2352 by 1568 pixels:
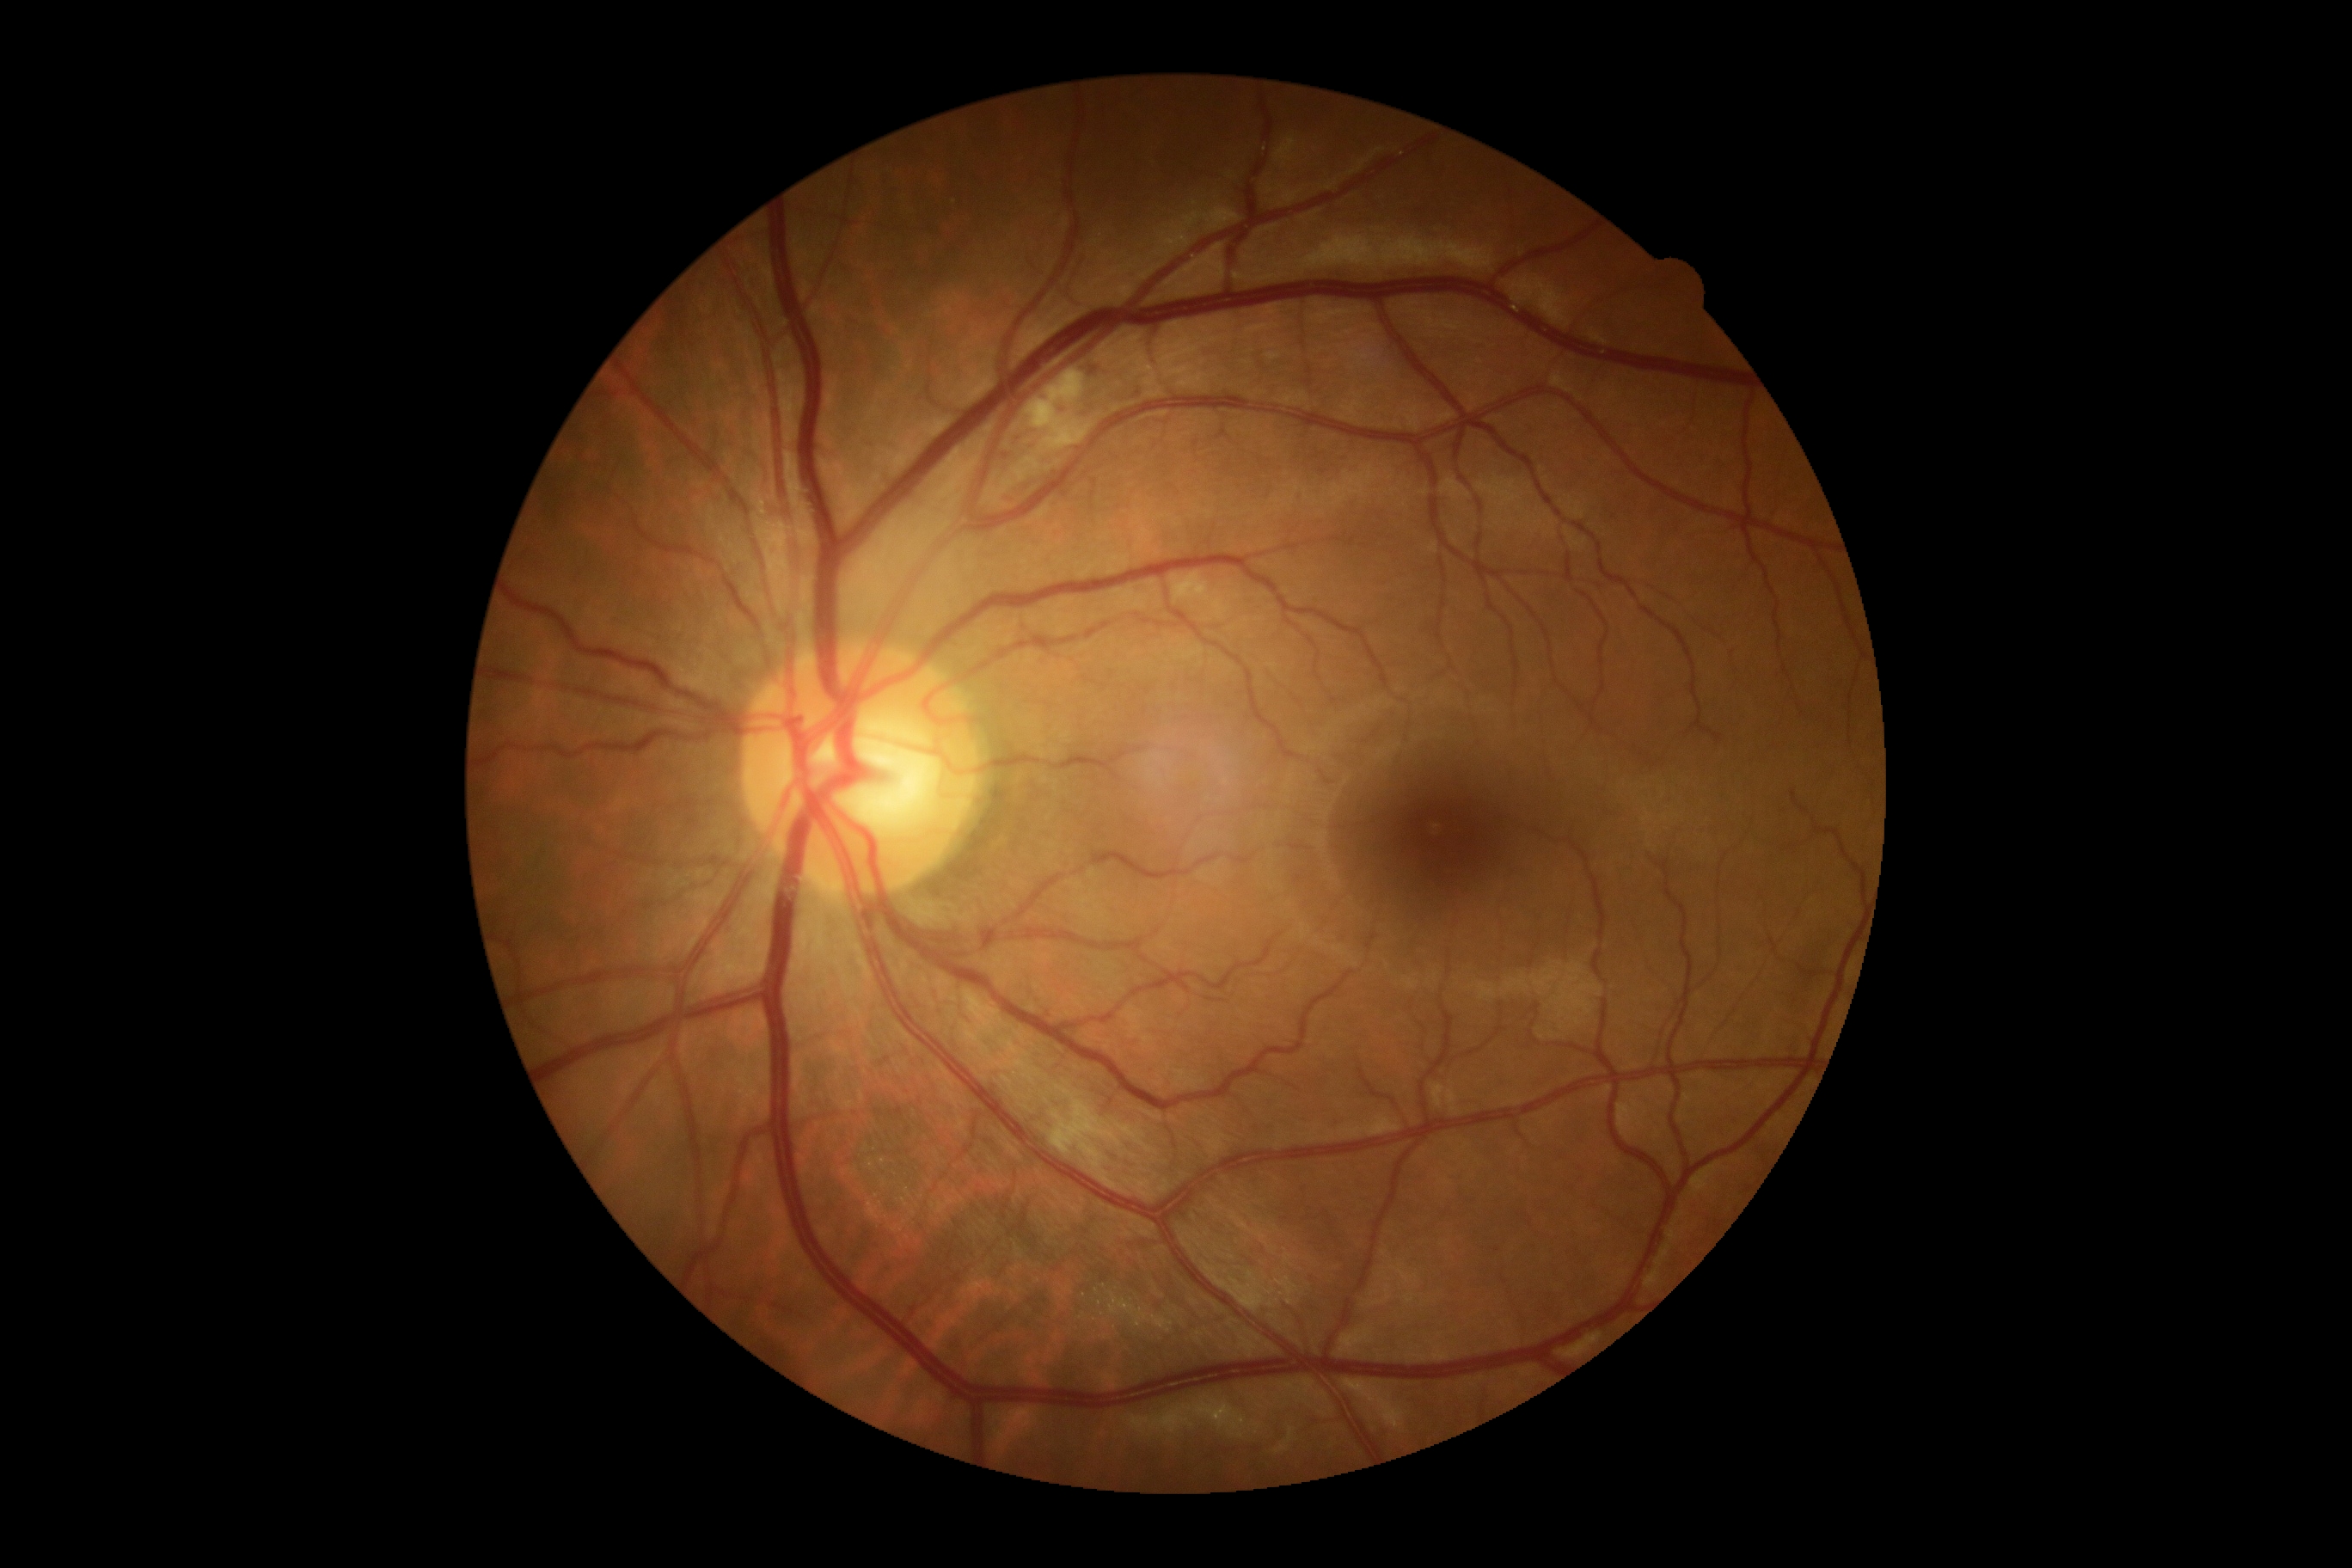
retinopathy grade: moderate non-proliferative diabetic retinopathy (2).